Wide-field fundus photograph of an infant. 100° field of view (Phoenix ICON) — 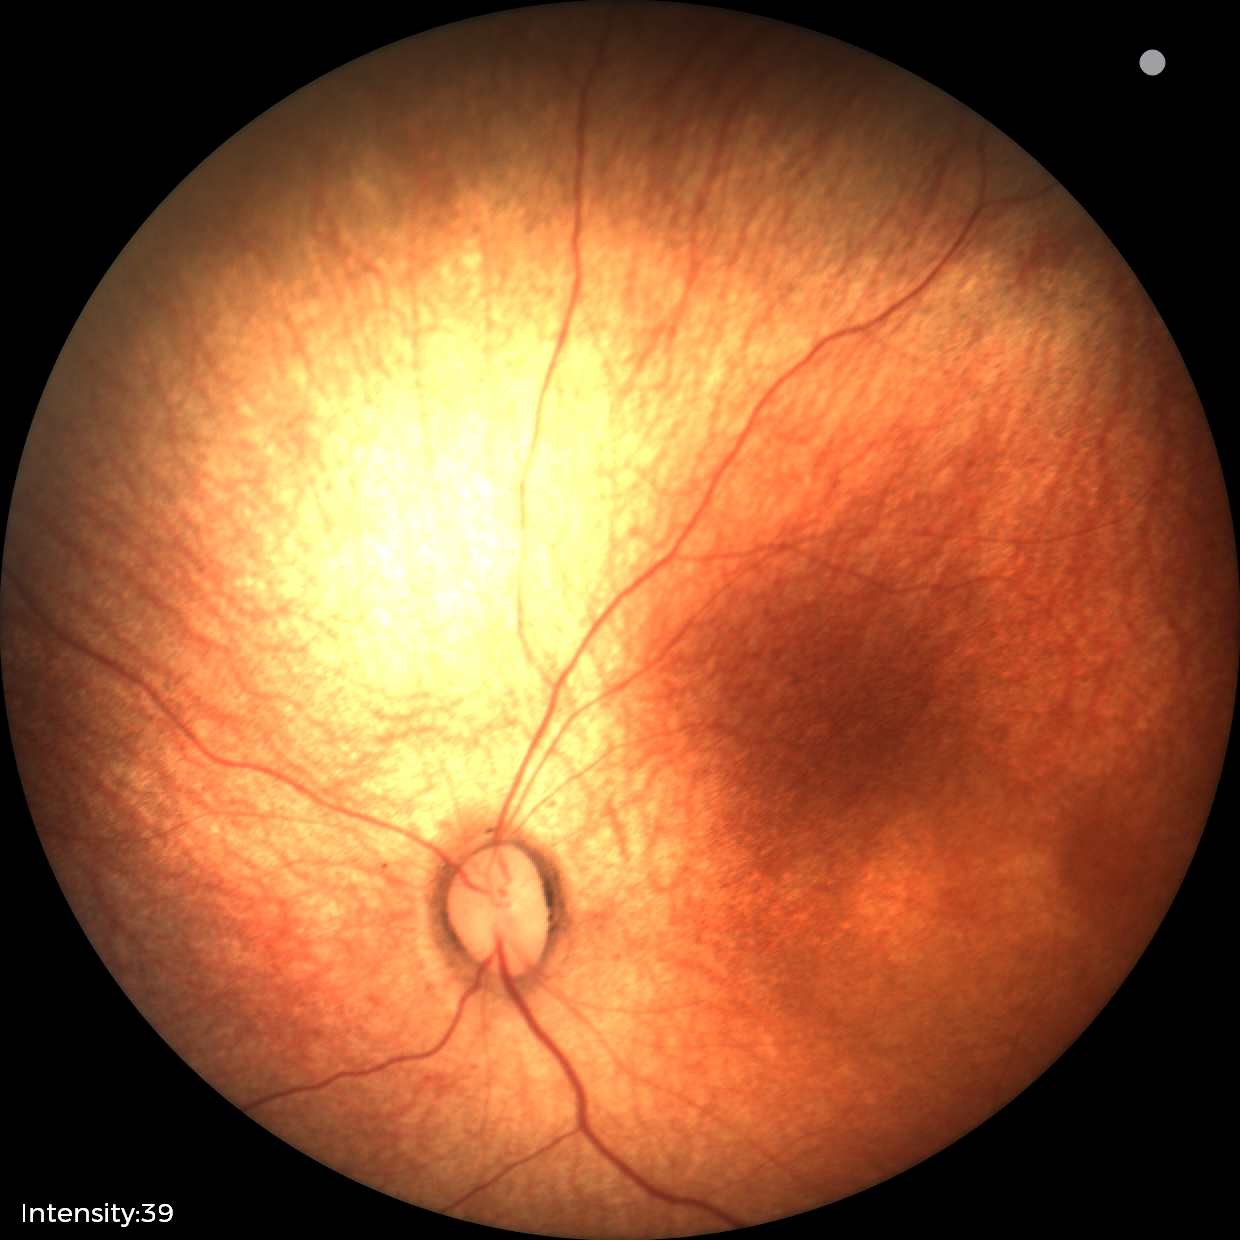

Physiological retinal appearance for postconceptual age.